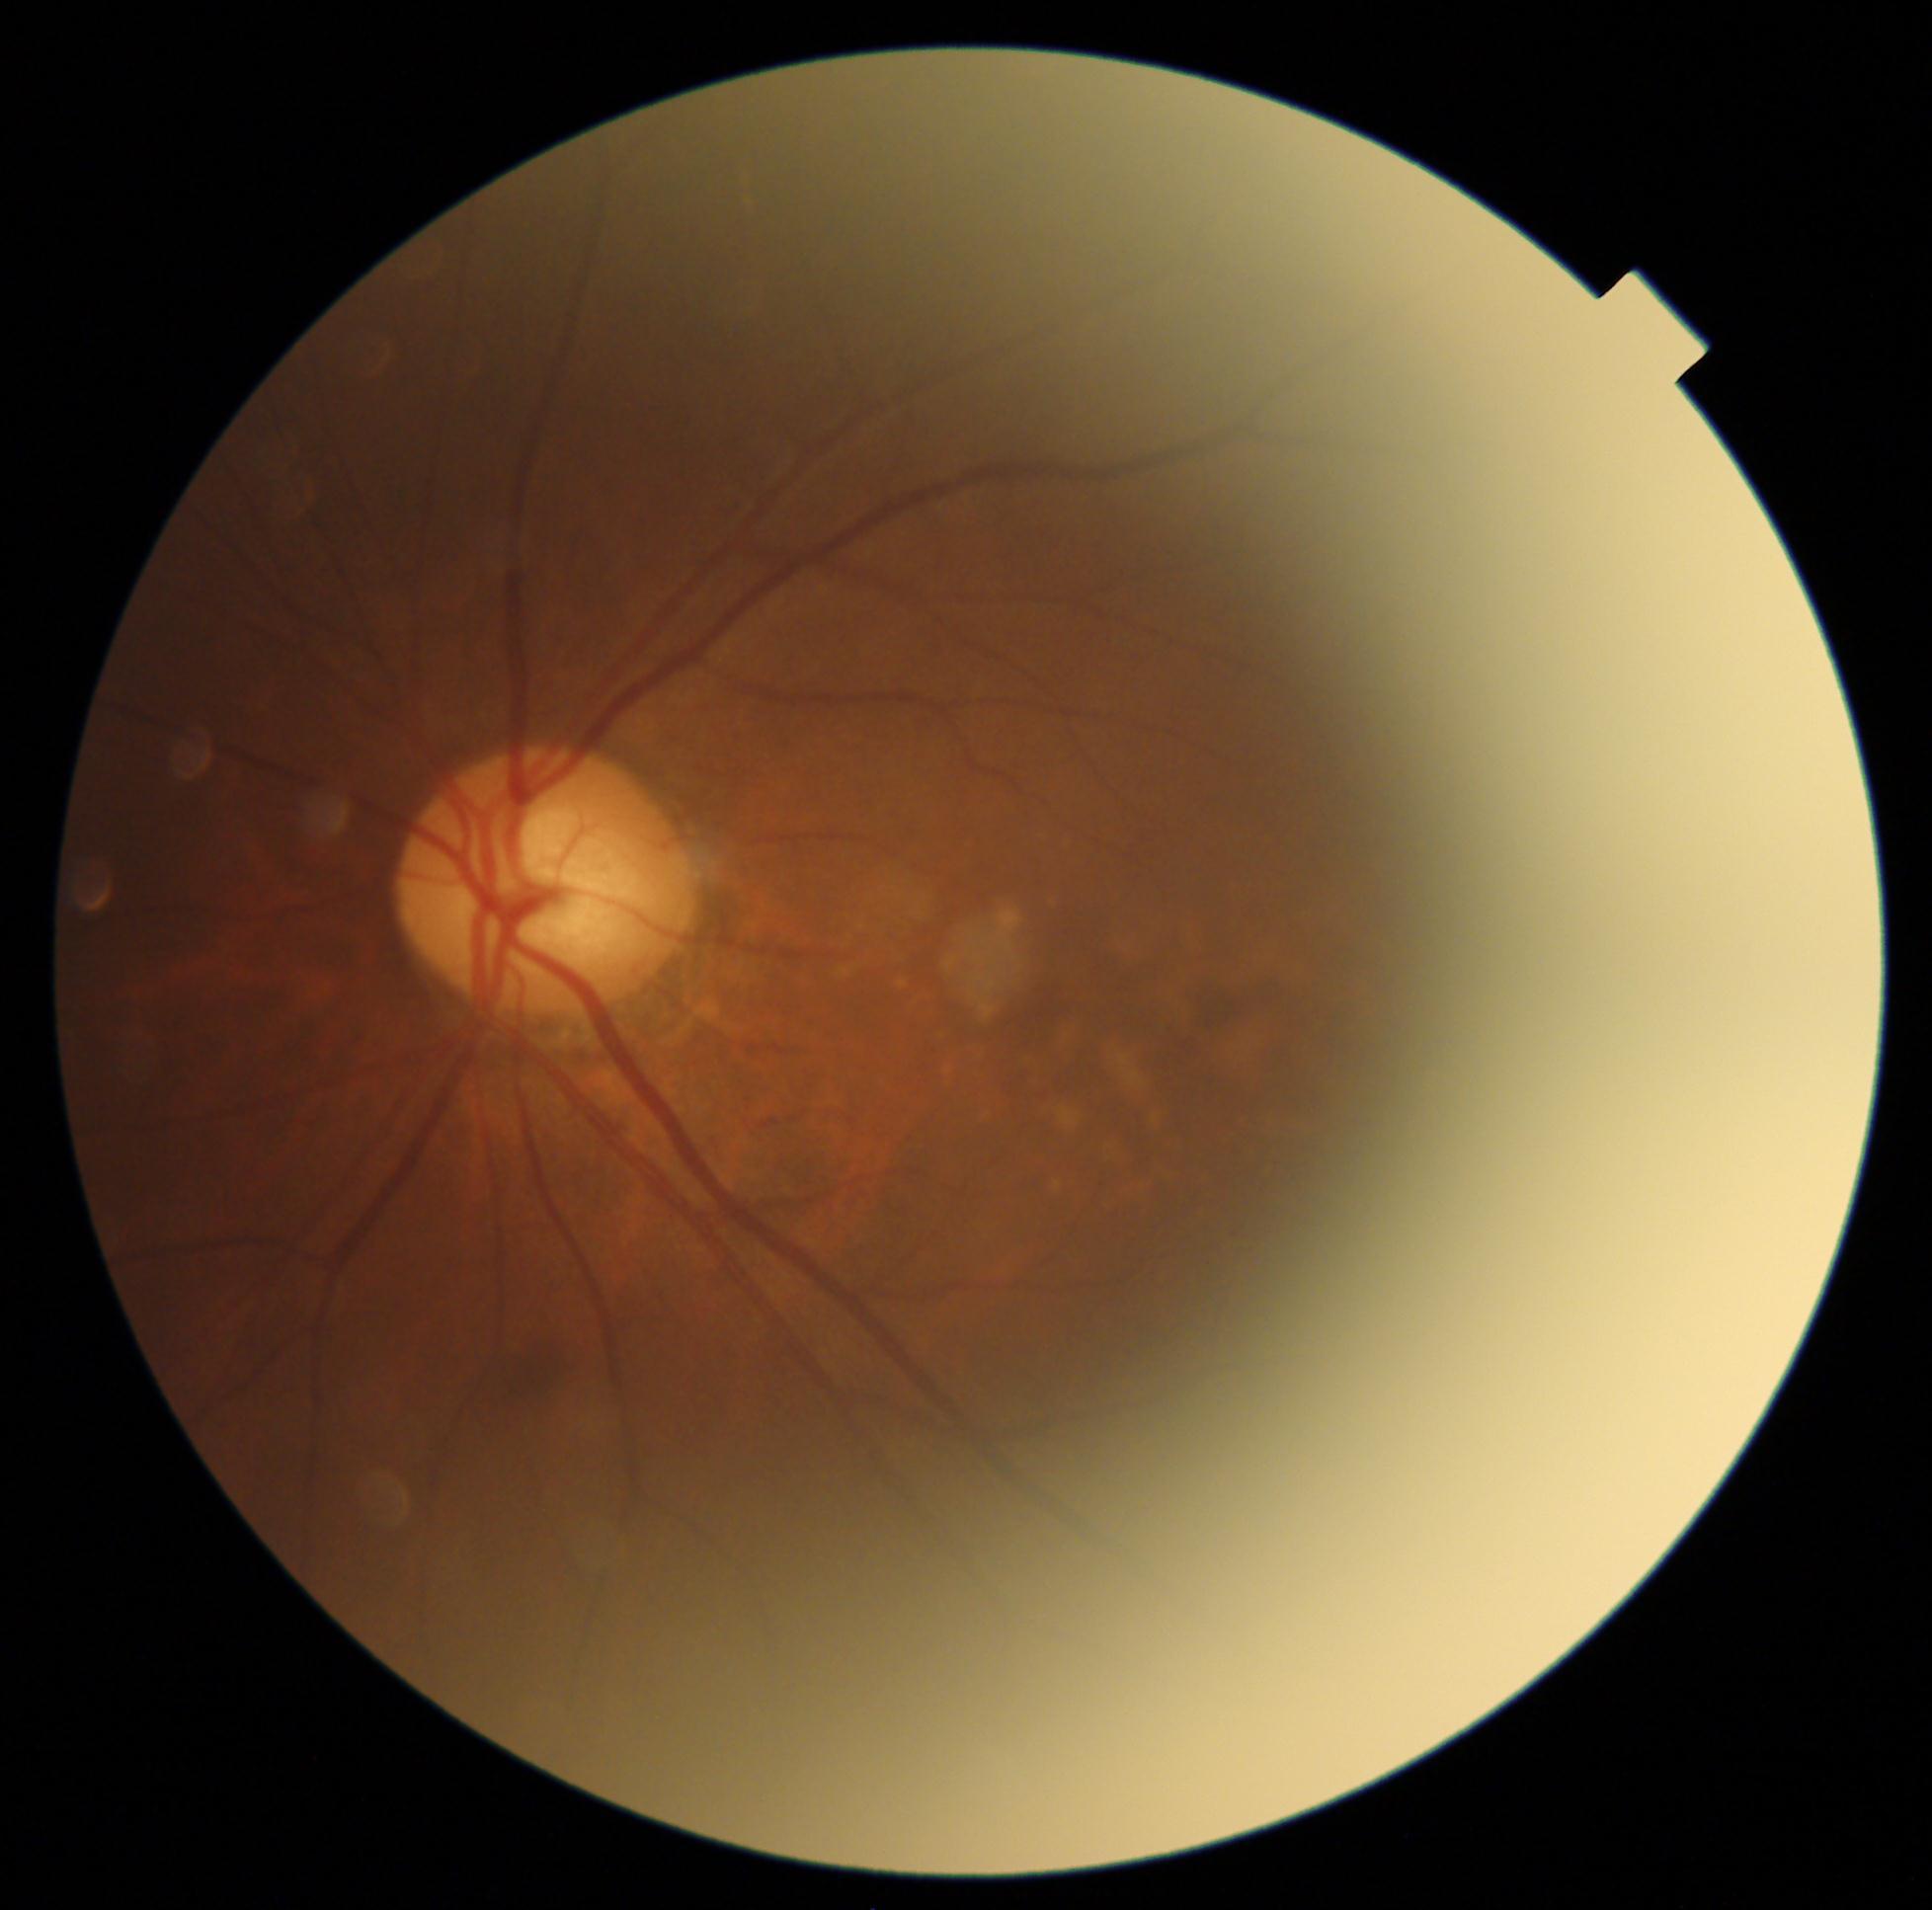
• diabetic retinopathy (DR) — 2/4 — more than just microaneurysms but less than severe NPDR
• DR class — non-proliferative diabetic retinopathy